ONH-centered crop from a color fundus image — 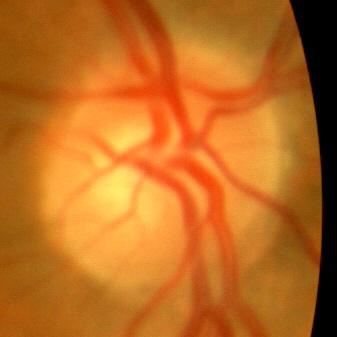
Q: Does this eye have glaucoma?
A: No glaucomatous findings.